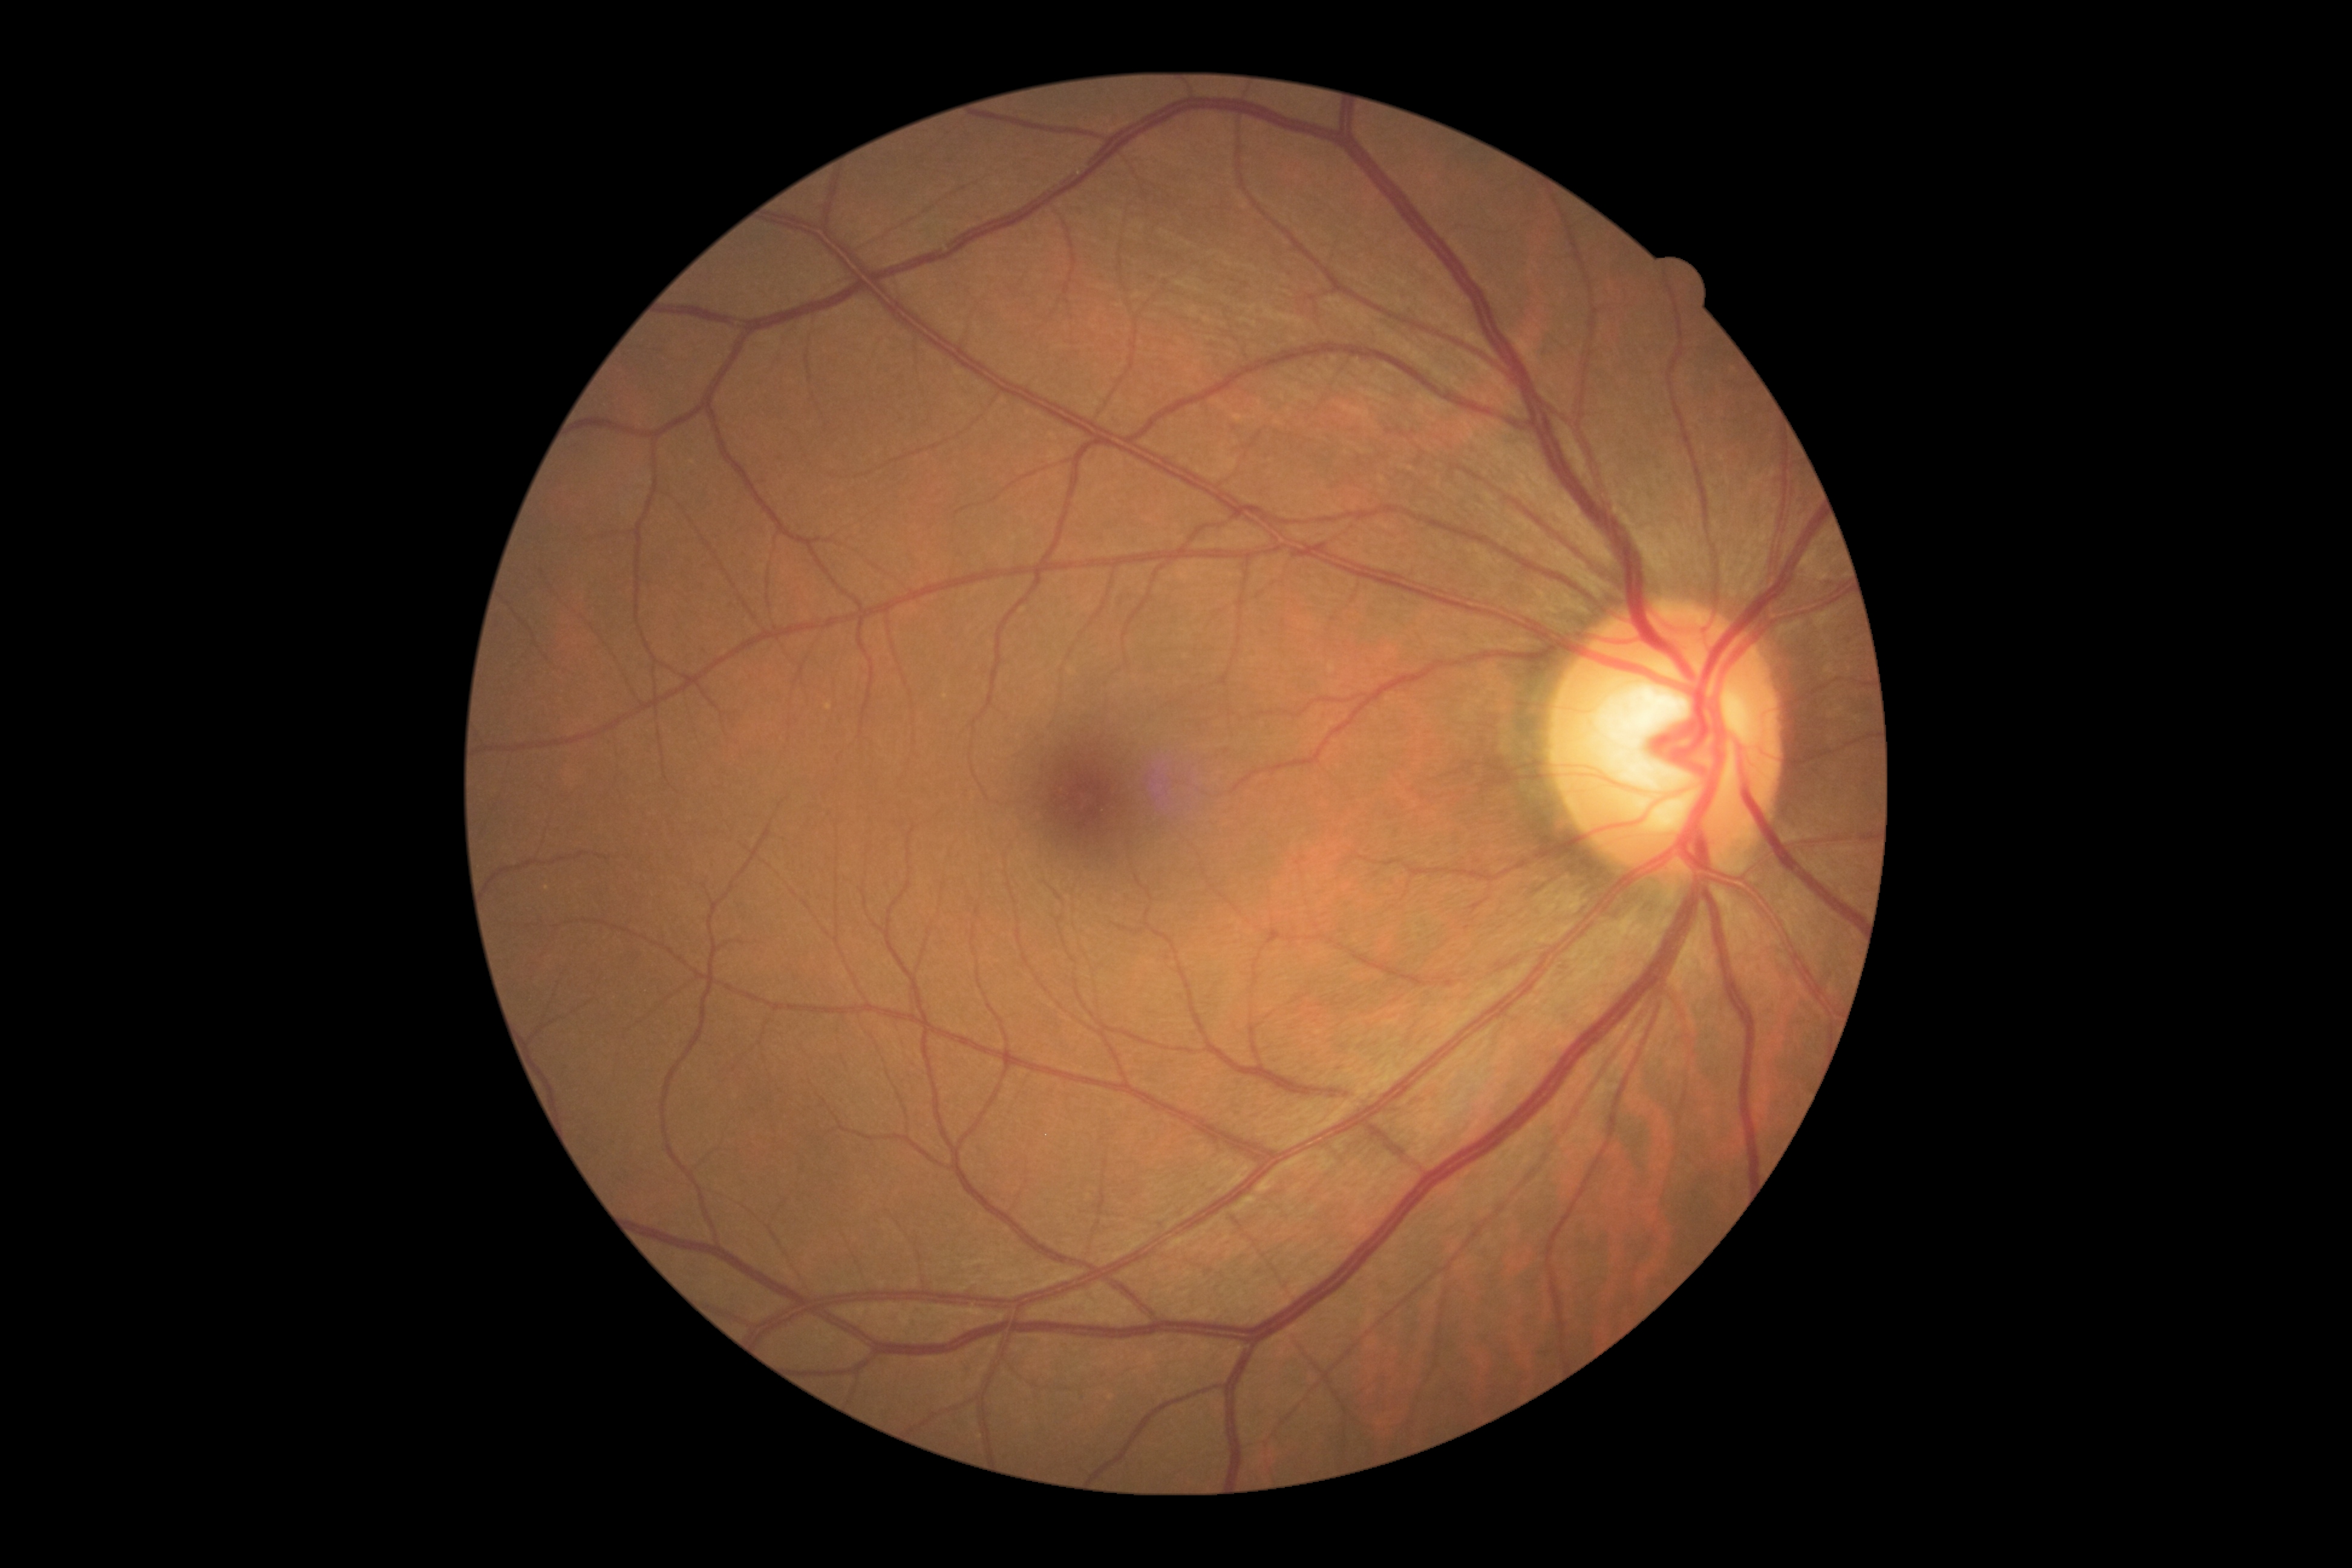

diabetic retinopathy=no apparent retinopathy (grade 0).